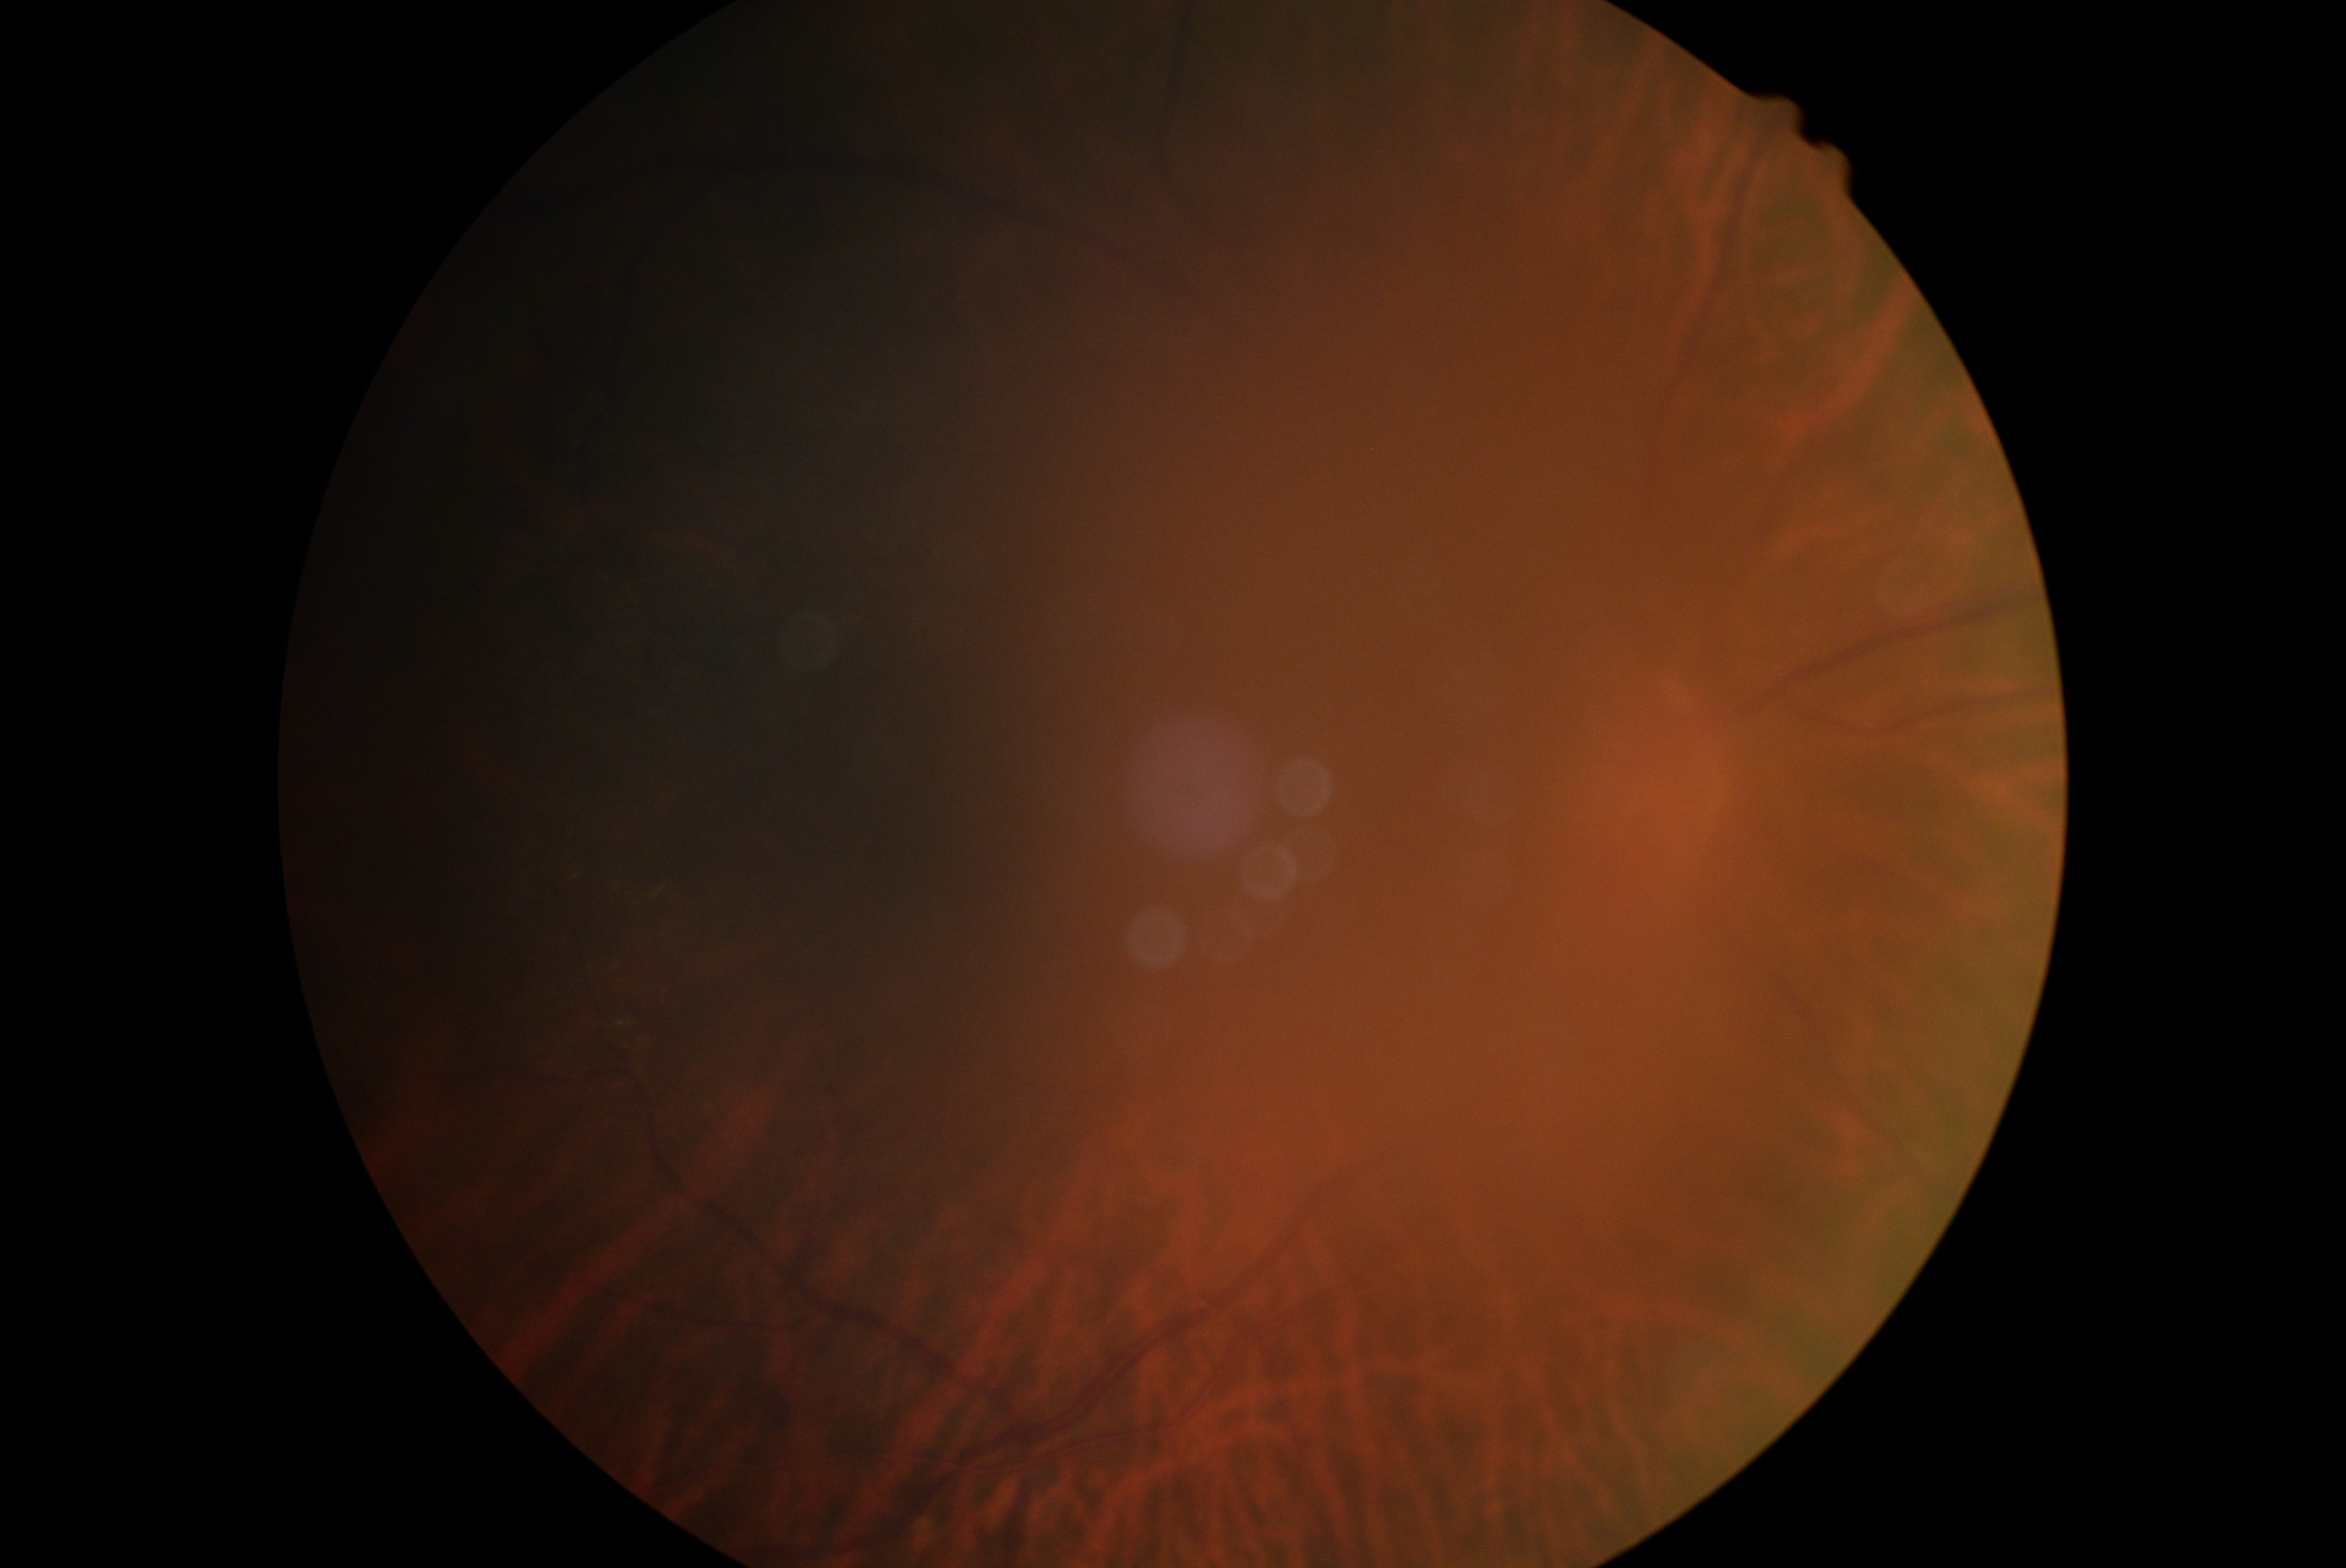
Diabetic retinopathy (DR) is ungradable.
Ungradable image — DR severity cannot be determined.